RetCam wide-field infant fundus image; Natus RetCam Envision, 130° FOV; 1440 x 1080 pixels: 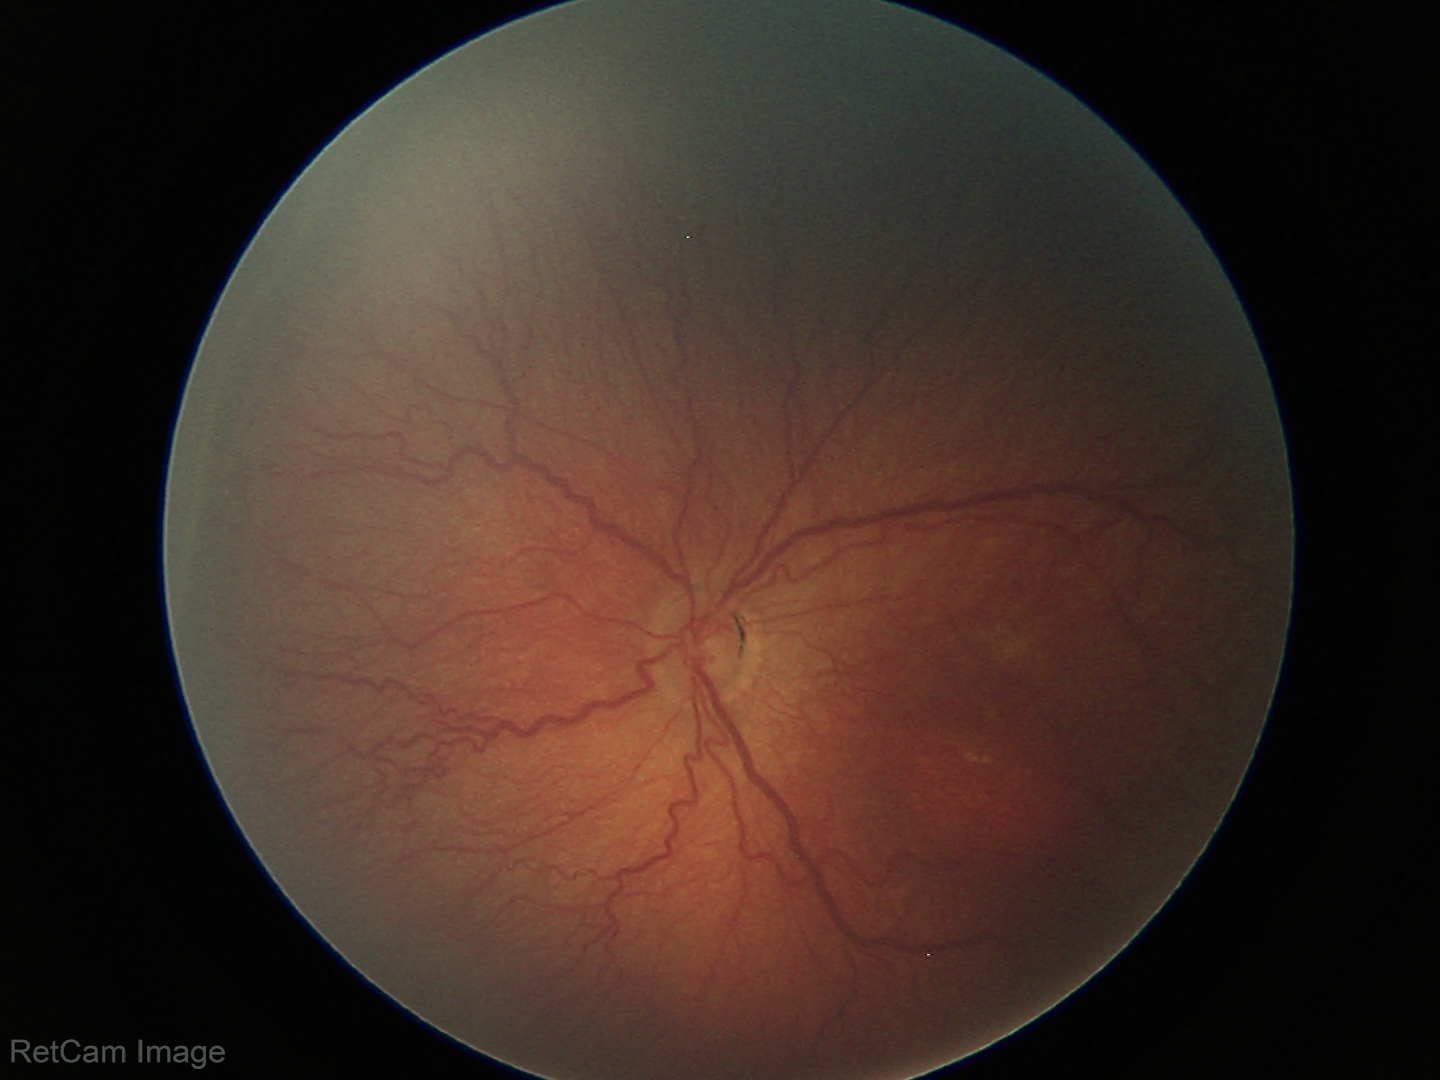
Q: What was the screening finding?
A: retinopathy of prematurity (ROP) stage 3
Q: What is the plus-form classification?
A: no plus disease